Wide-field fundus photograph from neonatal ROP screening.
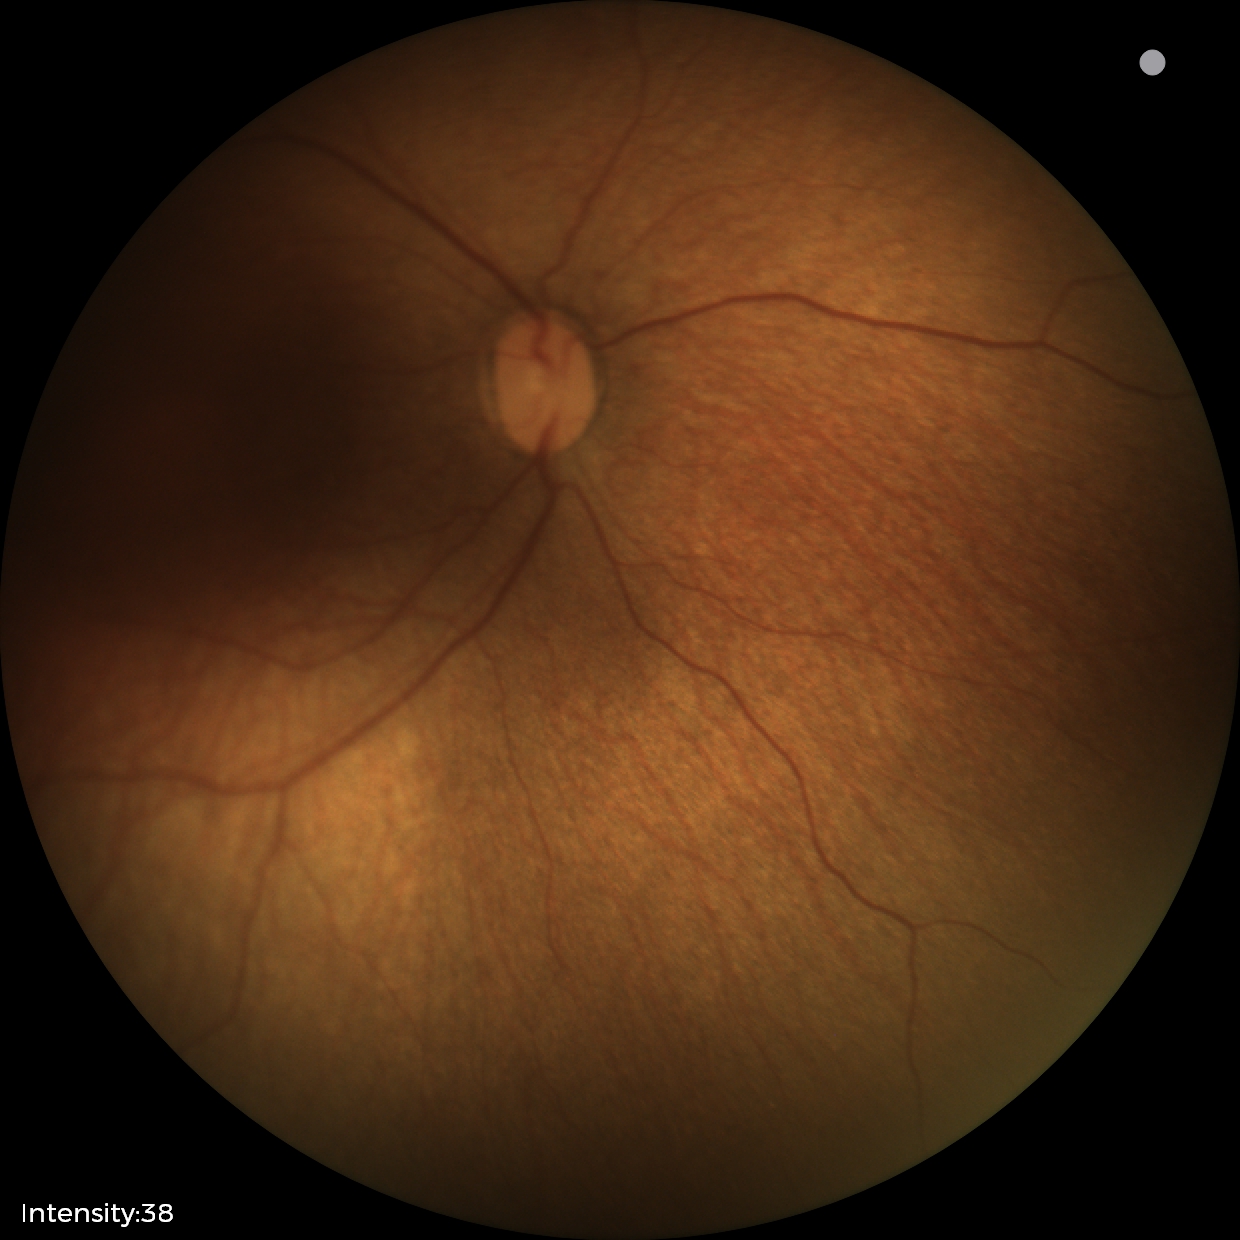

Diagnosis from this screening exam: status post ROP.
No plus disease.